Camera: Nidek AFC-330; non-mydriatic fundus camera
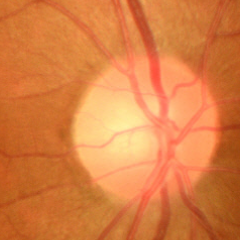

Q: Does this eye have glaucoma?
A: No glaucoma.